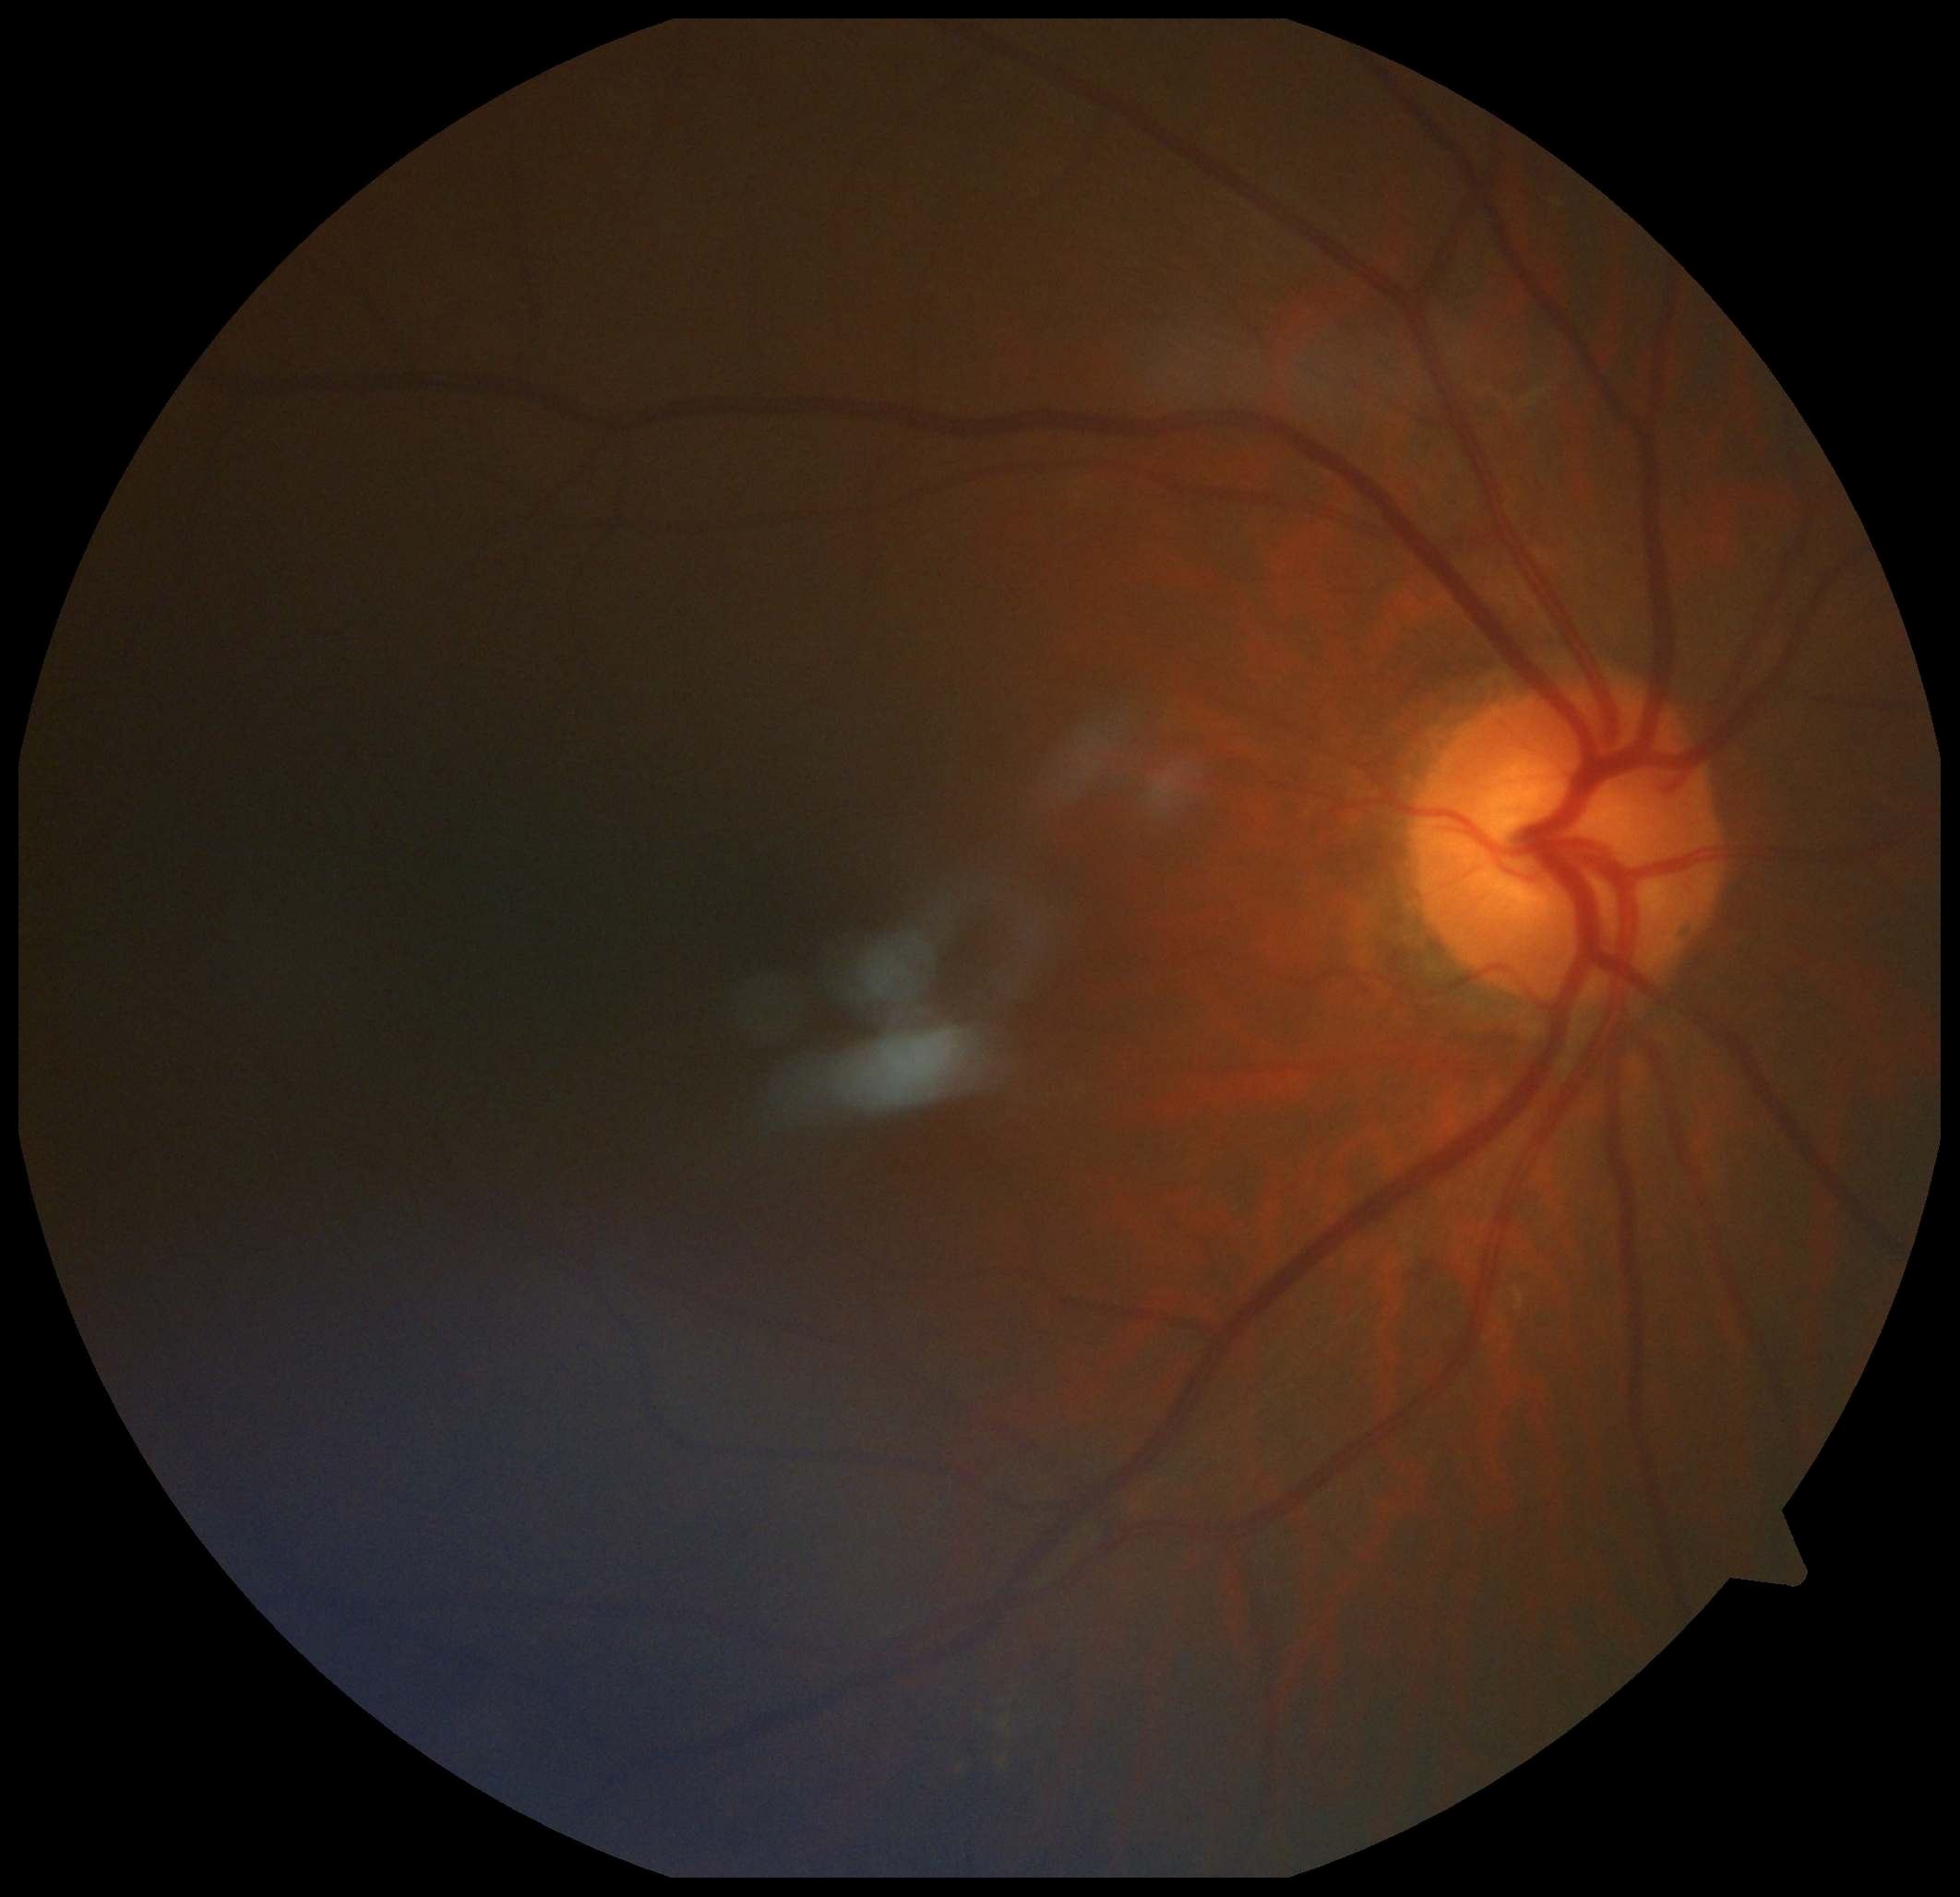

The retinopathy is classified as non-proliferative diabetic retinopathy.
DR stage is moderate non-proliferative diabetic retinopathy (grade 2).